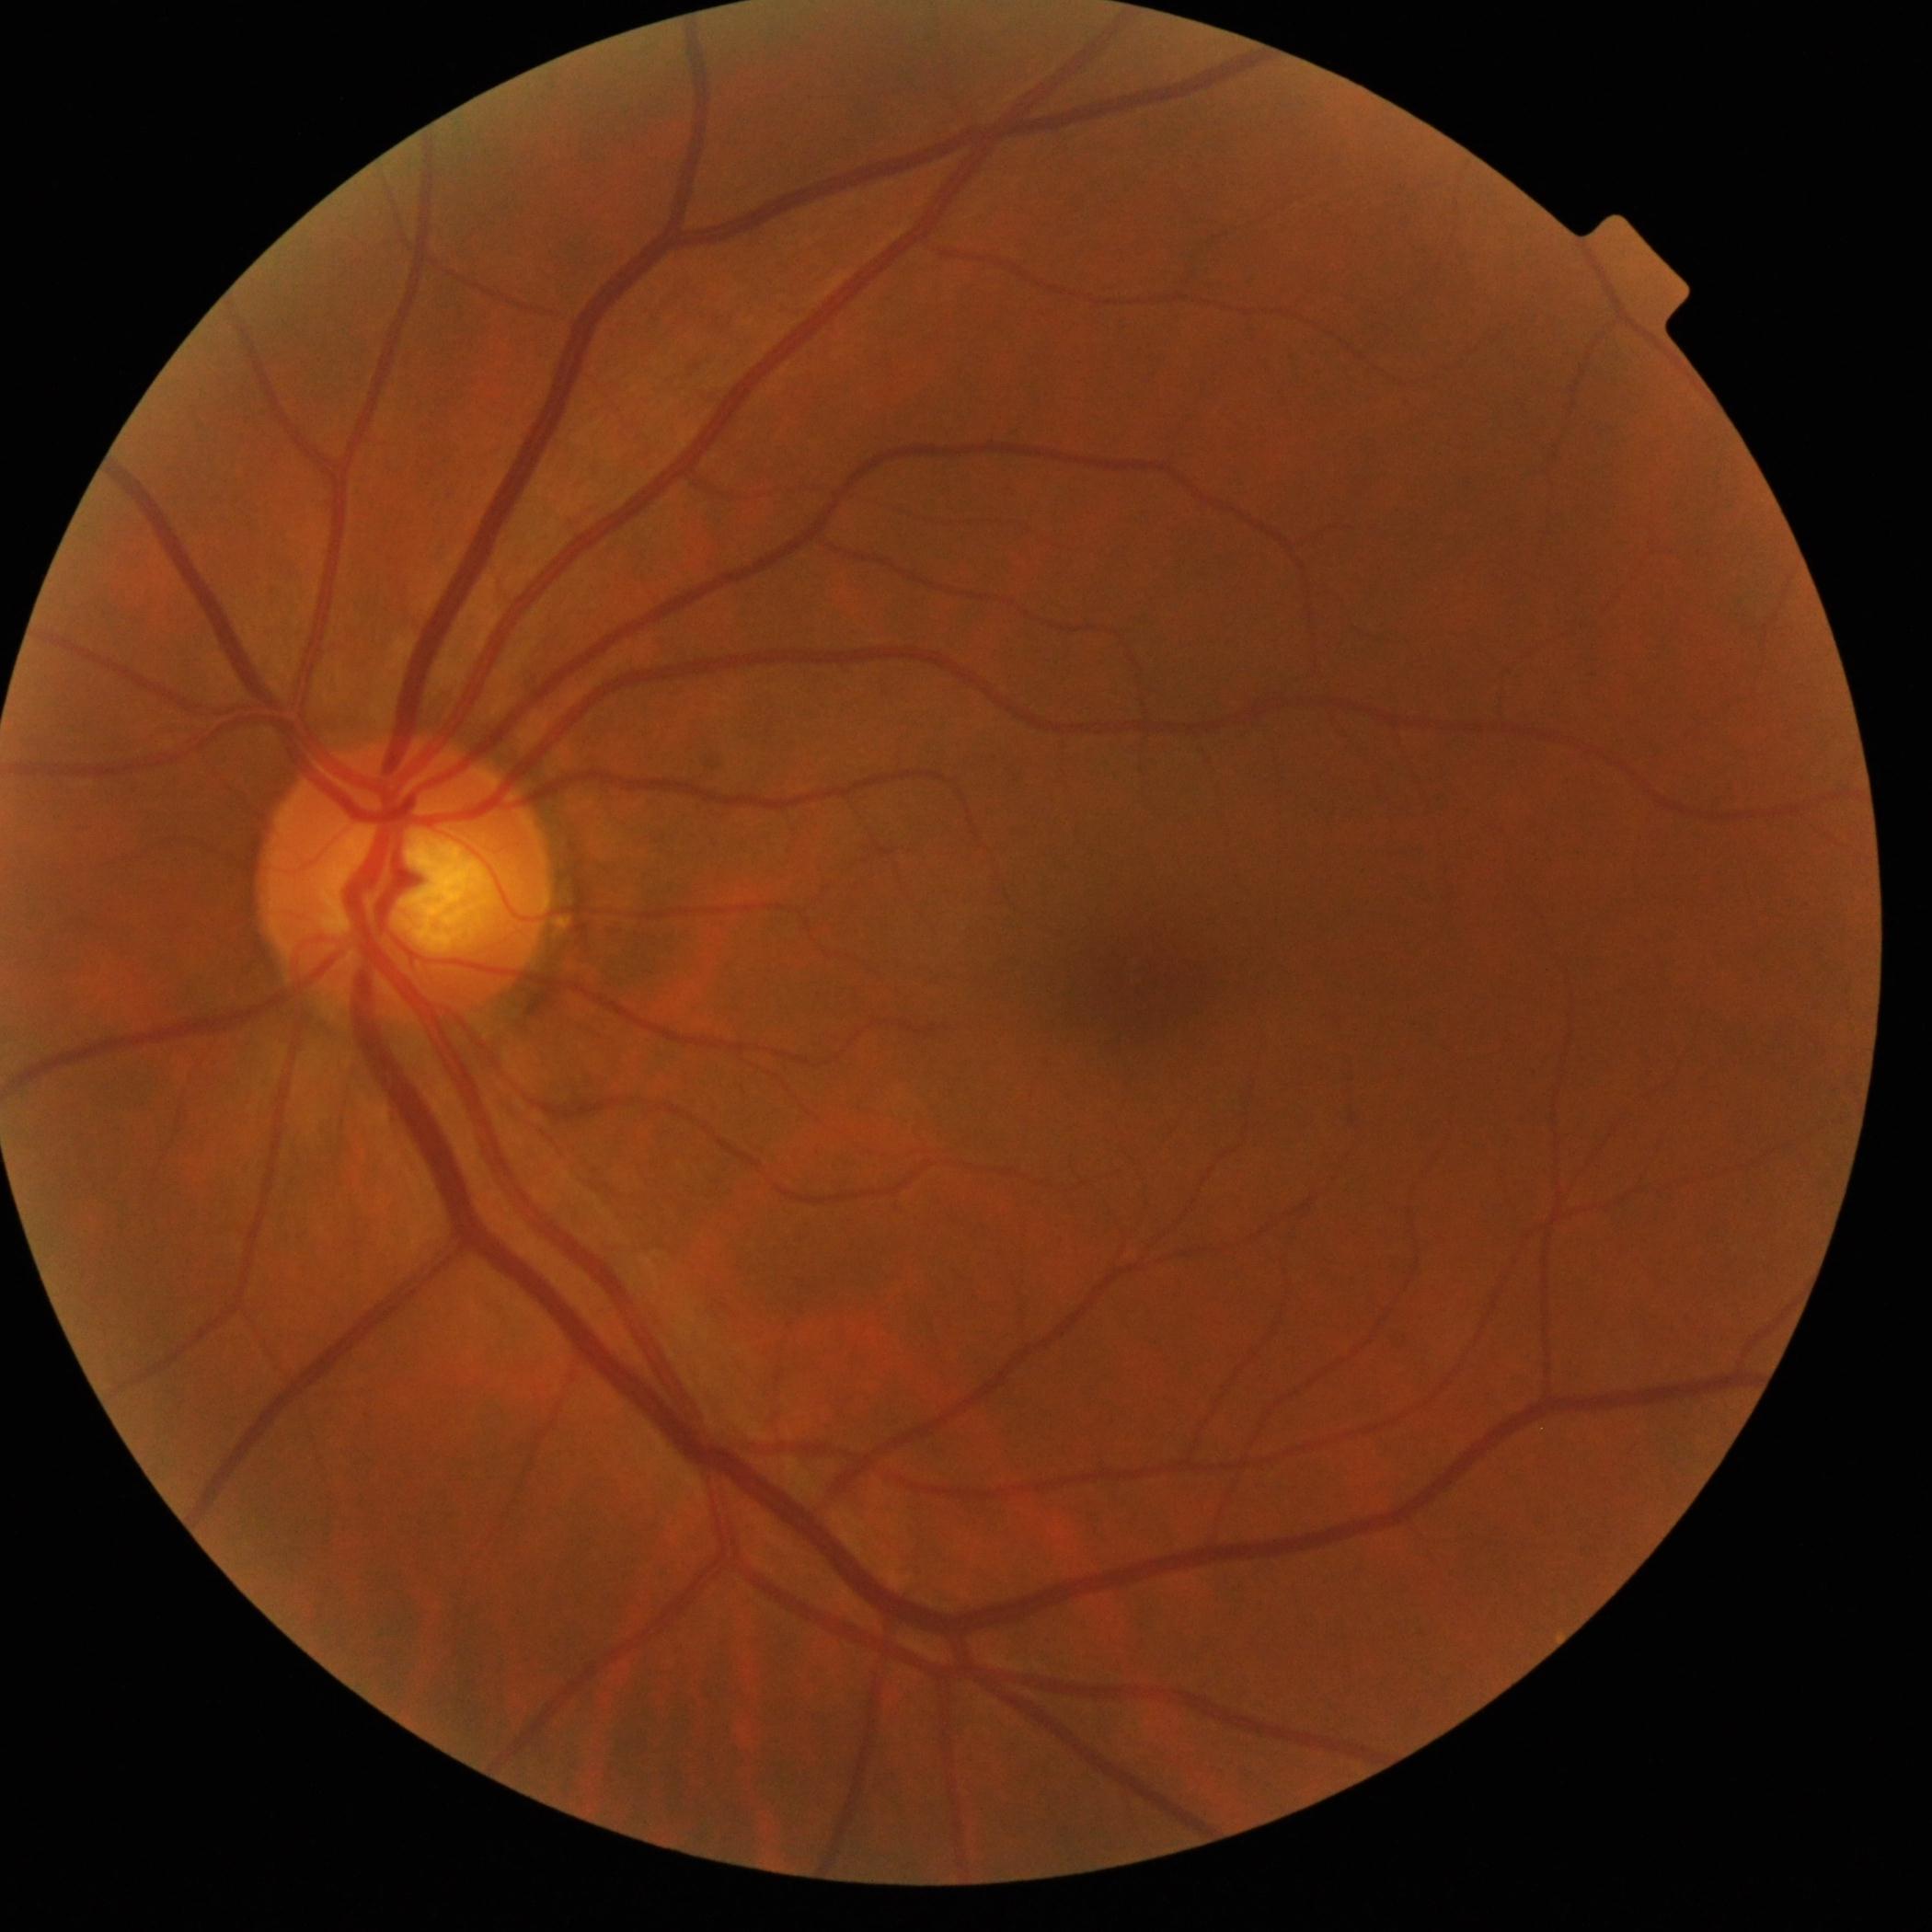
diabetic retinopathy (DR): 0.